Pediatric wide-field fundus photograph. 640 x 480 pixels.
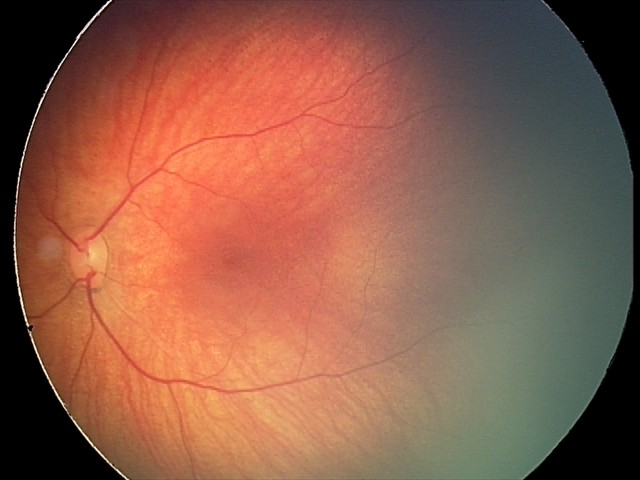

Screening examination consistent with retinal hemorrhages.